Modified Davis grading — 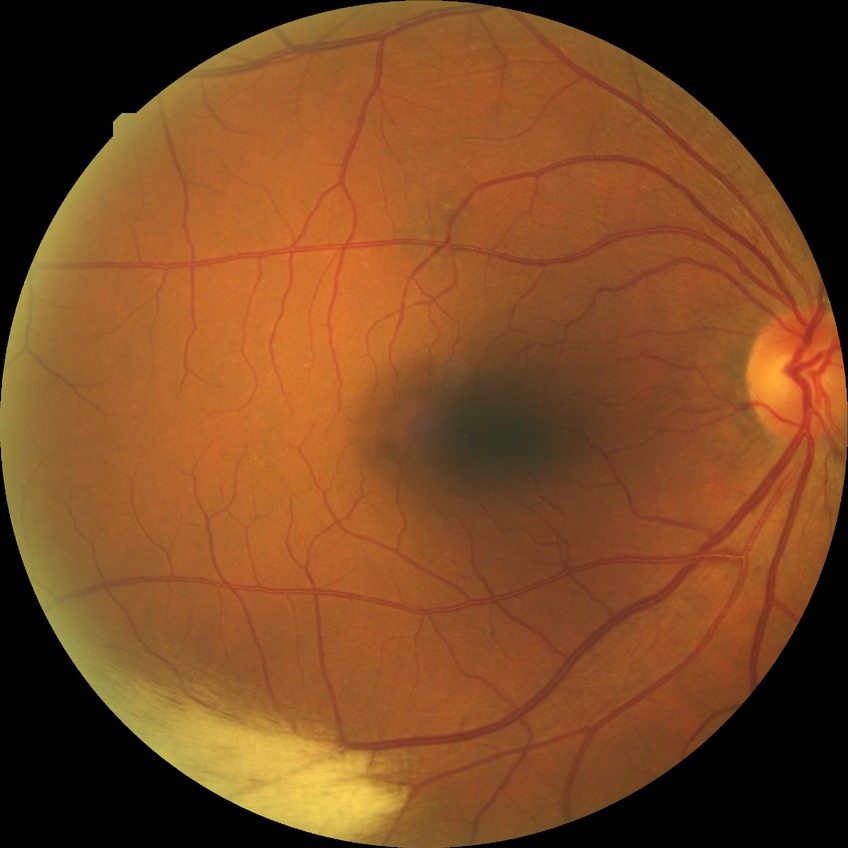
Diabetic retinopathy (DR) is no diabetic retinopathy (NDR).